NIDEK AFC-230; fundus photo: 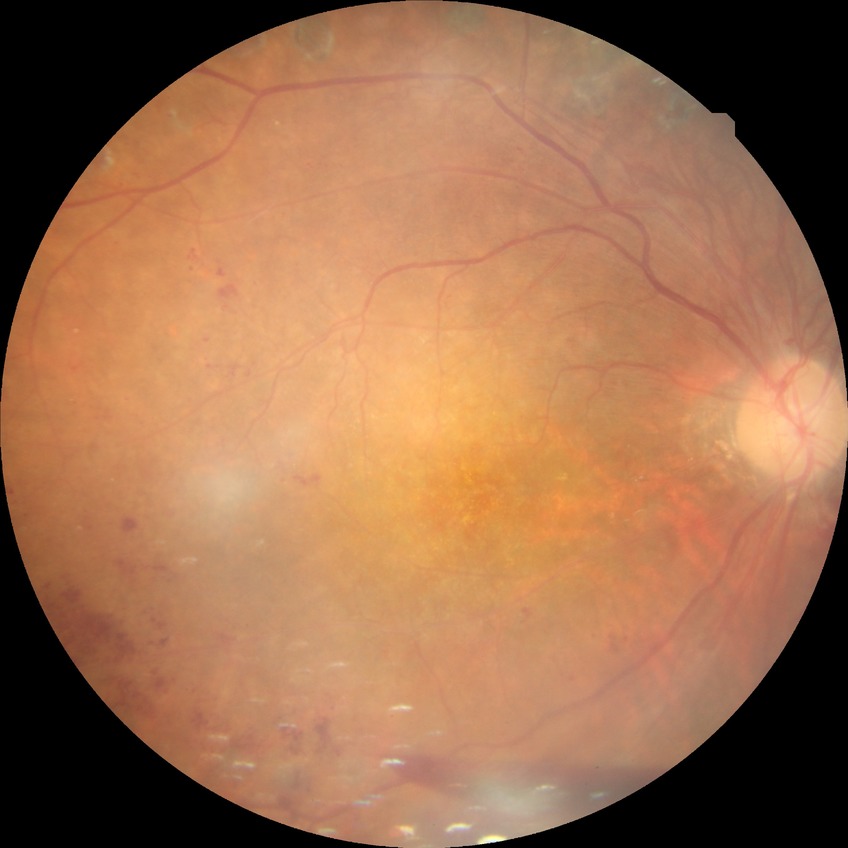 diabetic retinopathy stage = proliferative diabetic retinopathy